Fundus photo · Remidio Fundus on Phone — 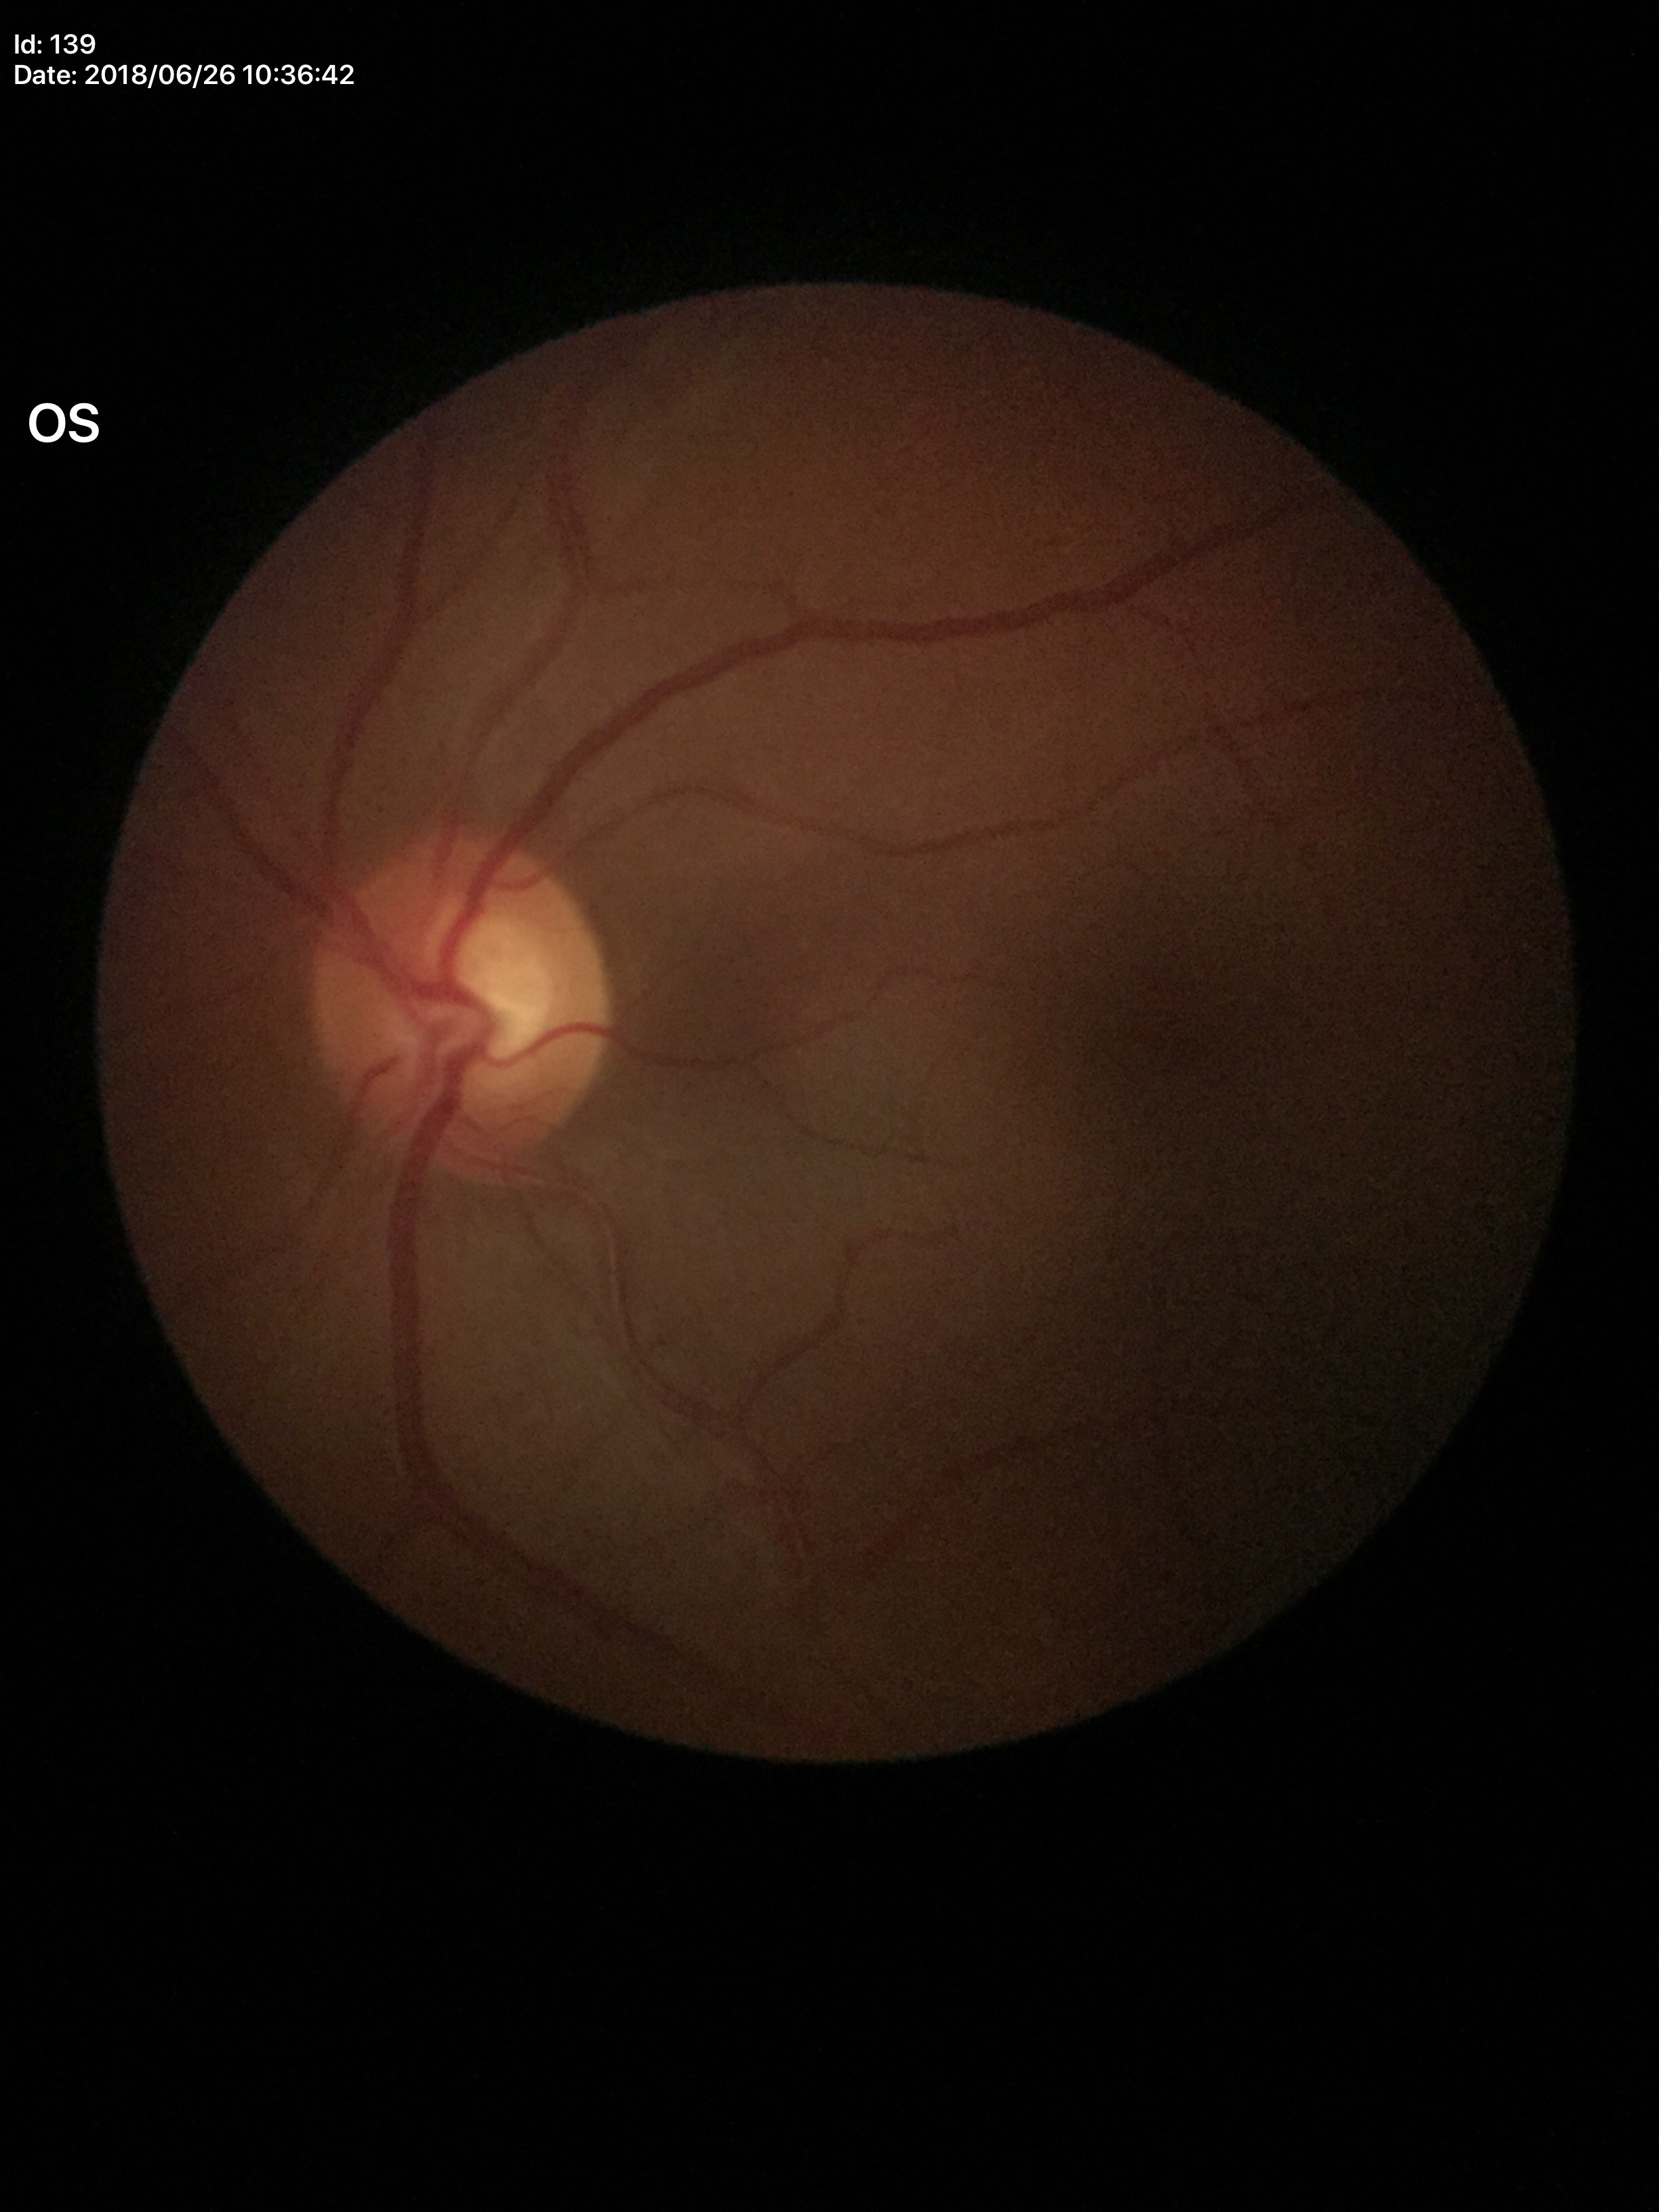 Negative for glaucoma suspicion (two of five ophthalmologists flagged glaucoma suspect). Vertical cup-disc ratio: 0.56.